1536x1152px, color fundus photograph, 45° field of view
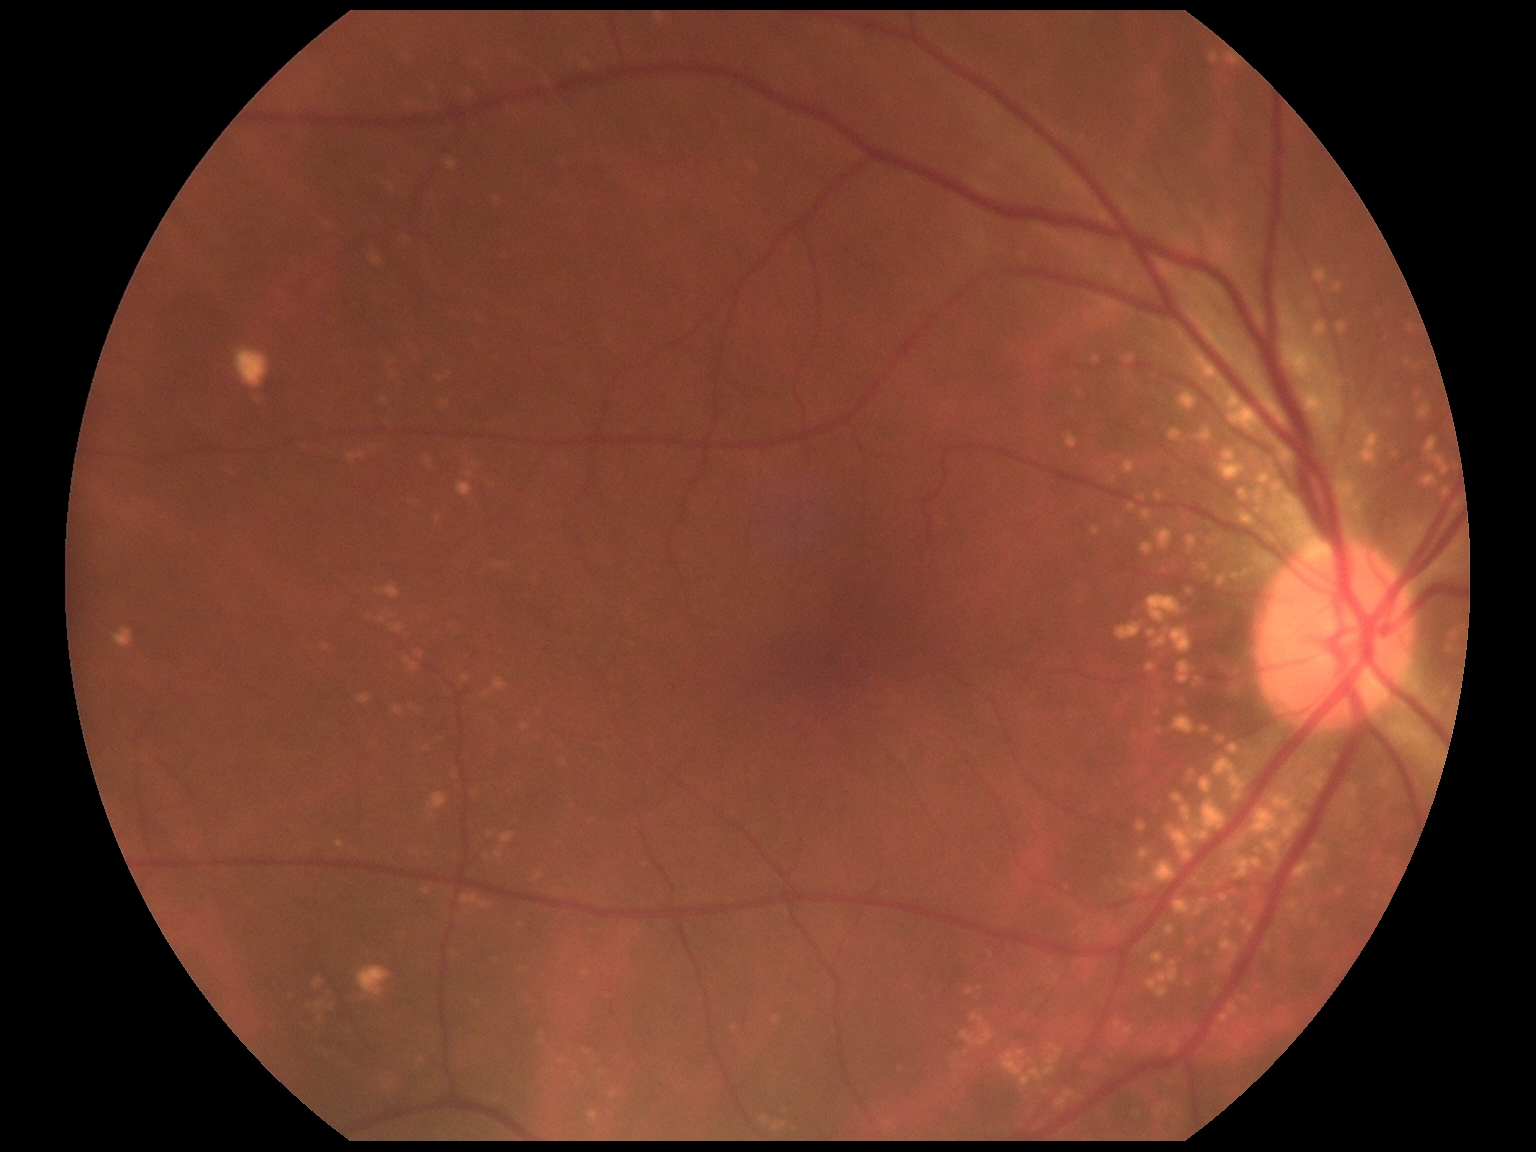

No diabetic retinal disease findings. DR is no apparent retinopathy (grade 0).